Wide-field fundus photograph of an infant: 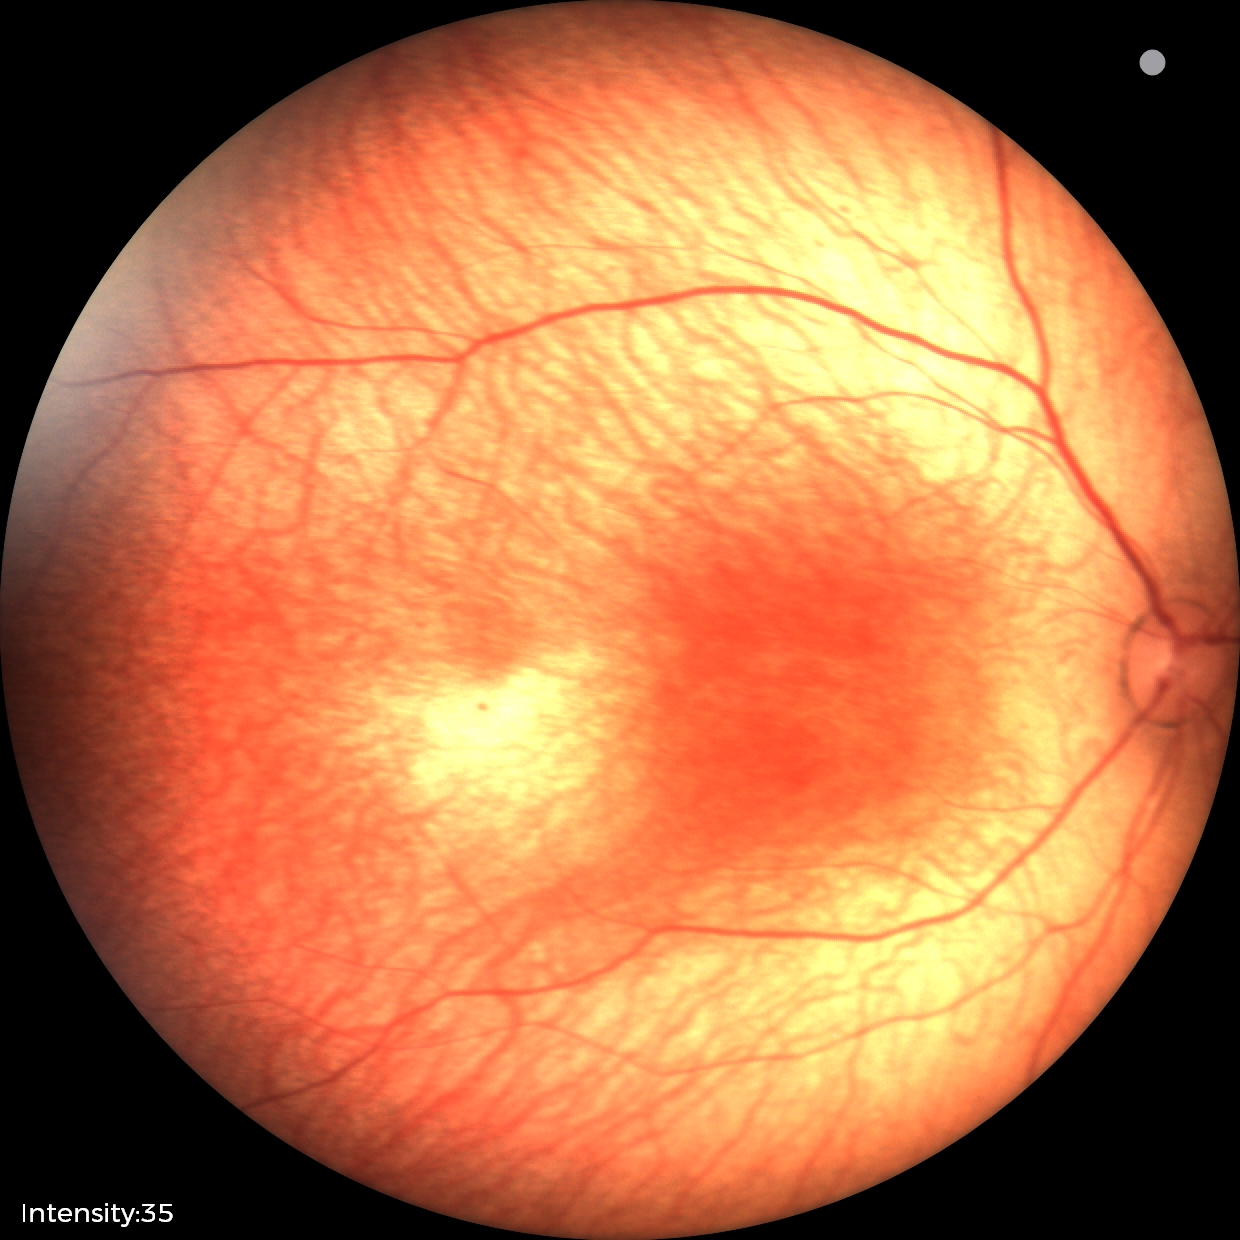

Screening: physiological retinal finding.